Infant wide-field fundus photograph. 640x480. 130° field of view (Clarity RetCam 3)
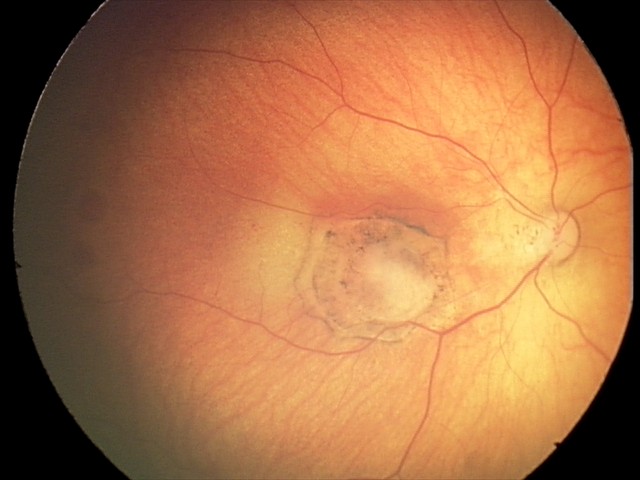

Examination diagnosed as toxoplasmosis chorioretinitis.